Retinal fundus photograph — 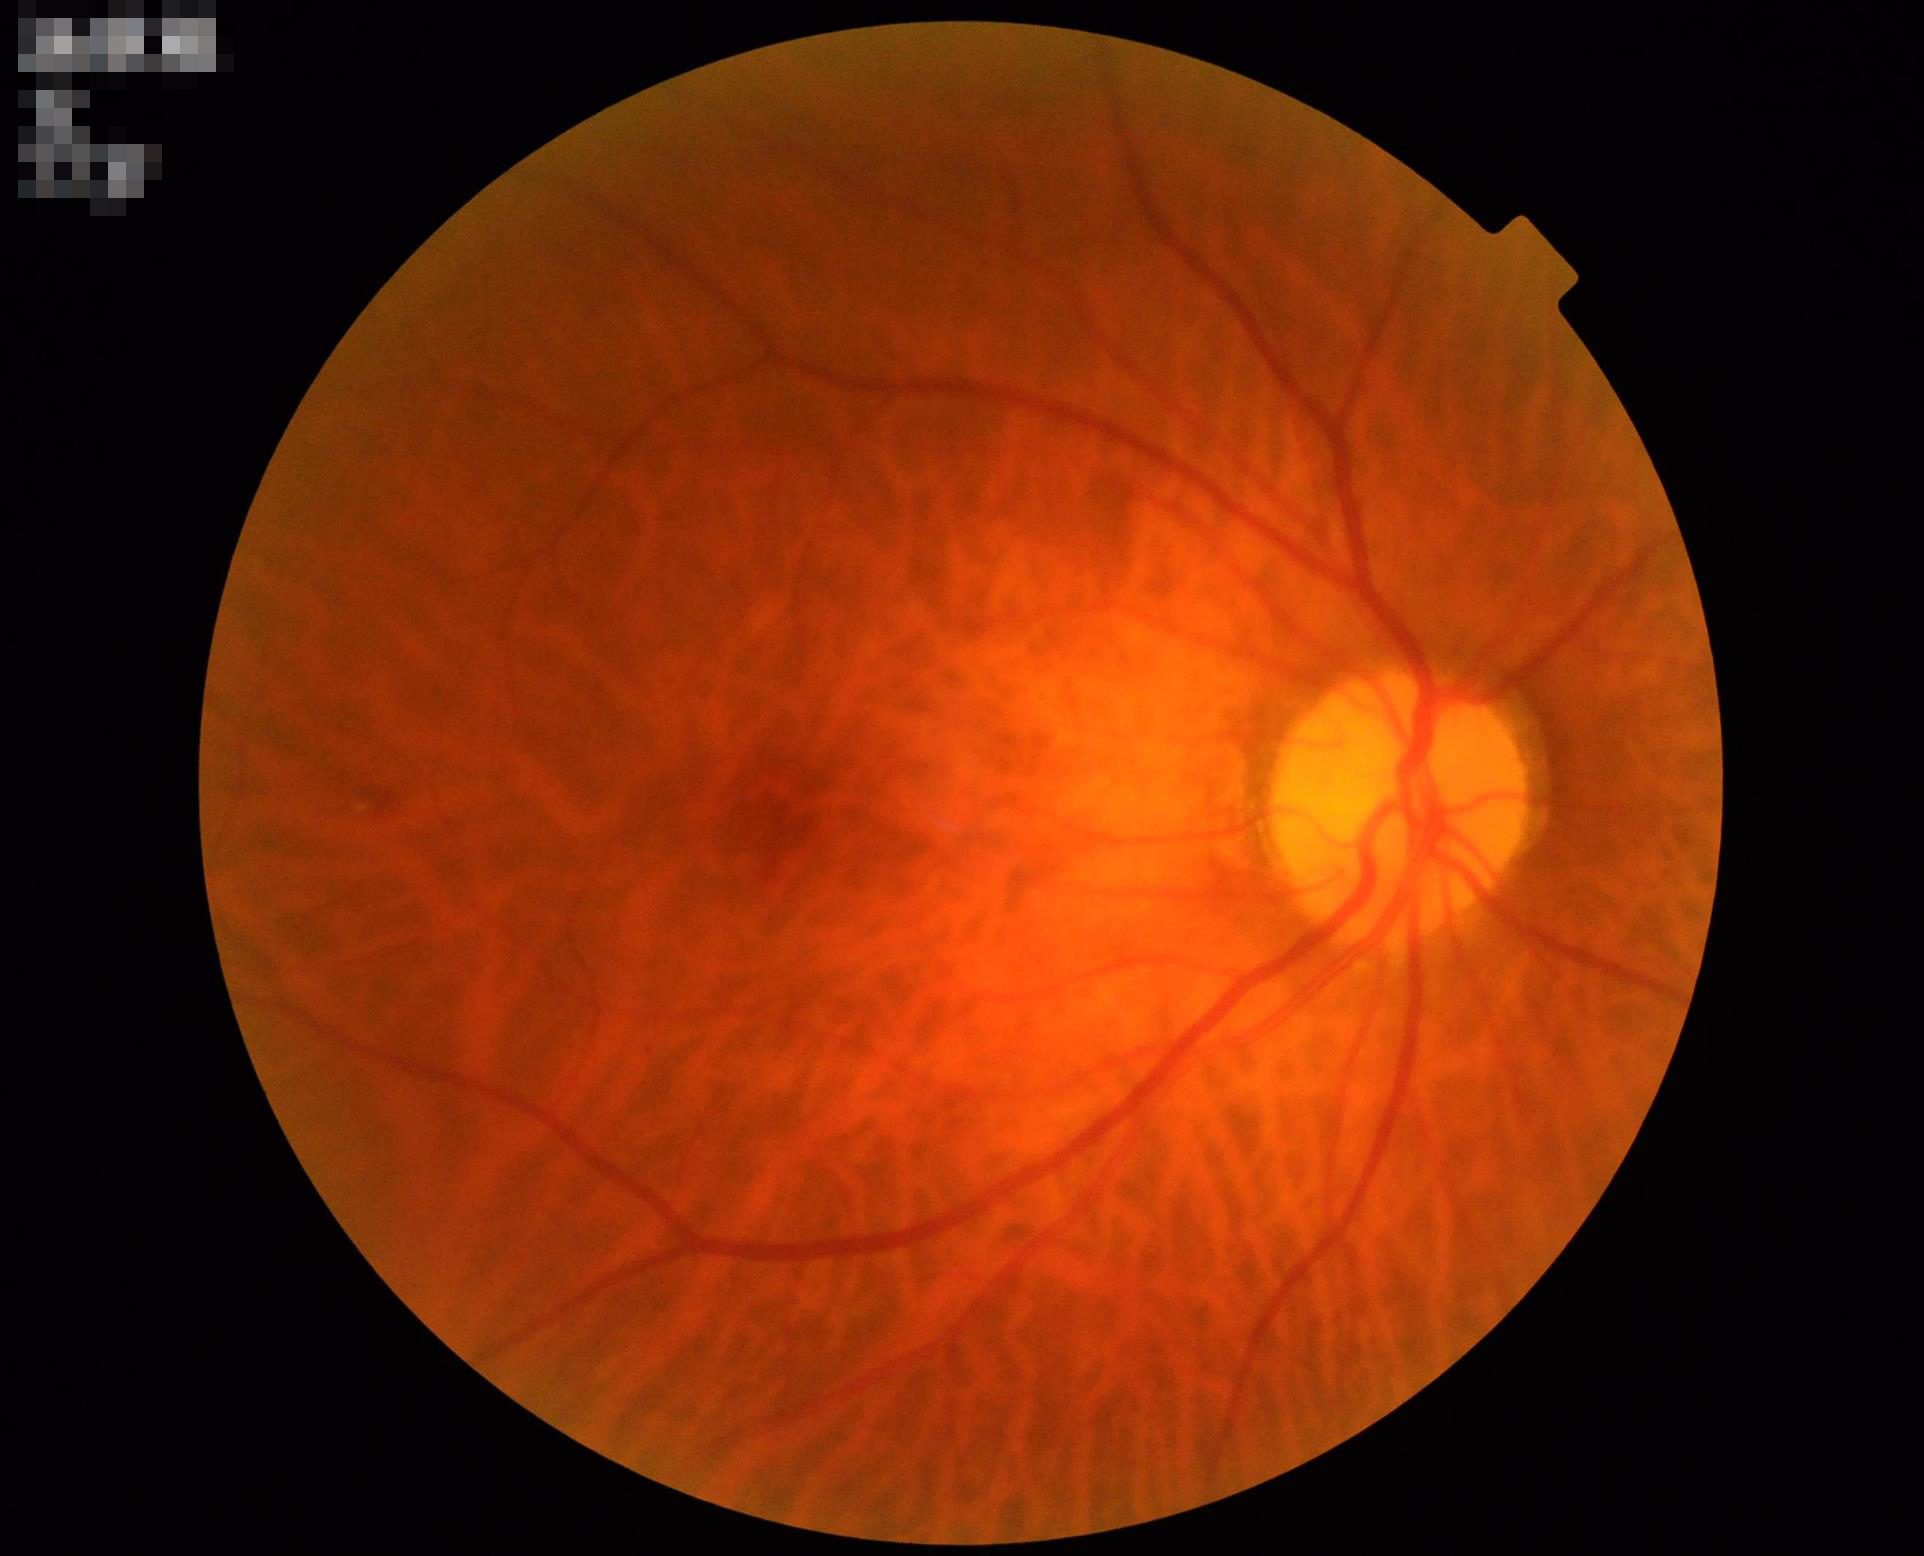

No over- or under-exposure.
Contrast is good.
Overall quality is good and the image is gradable.